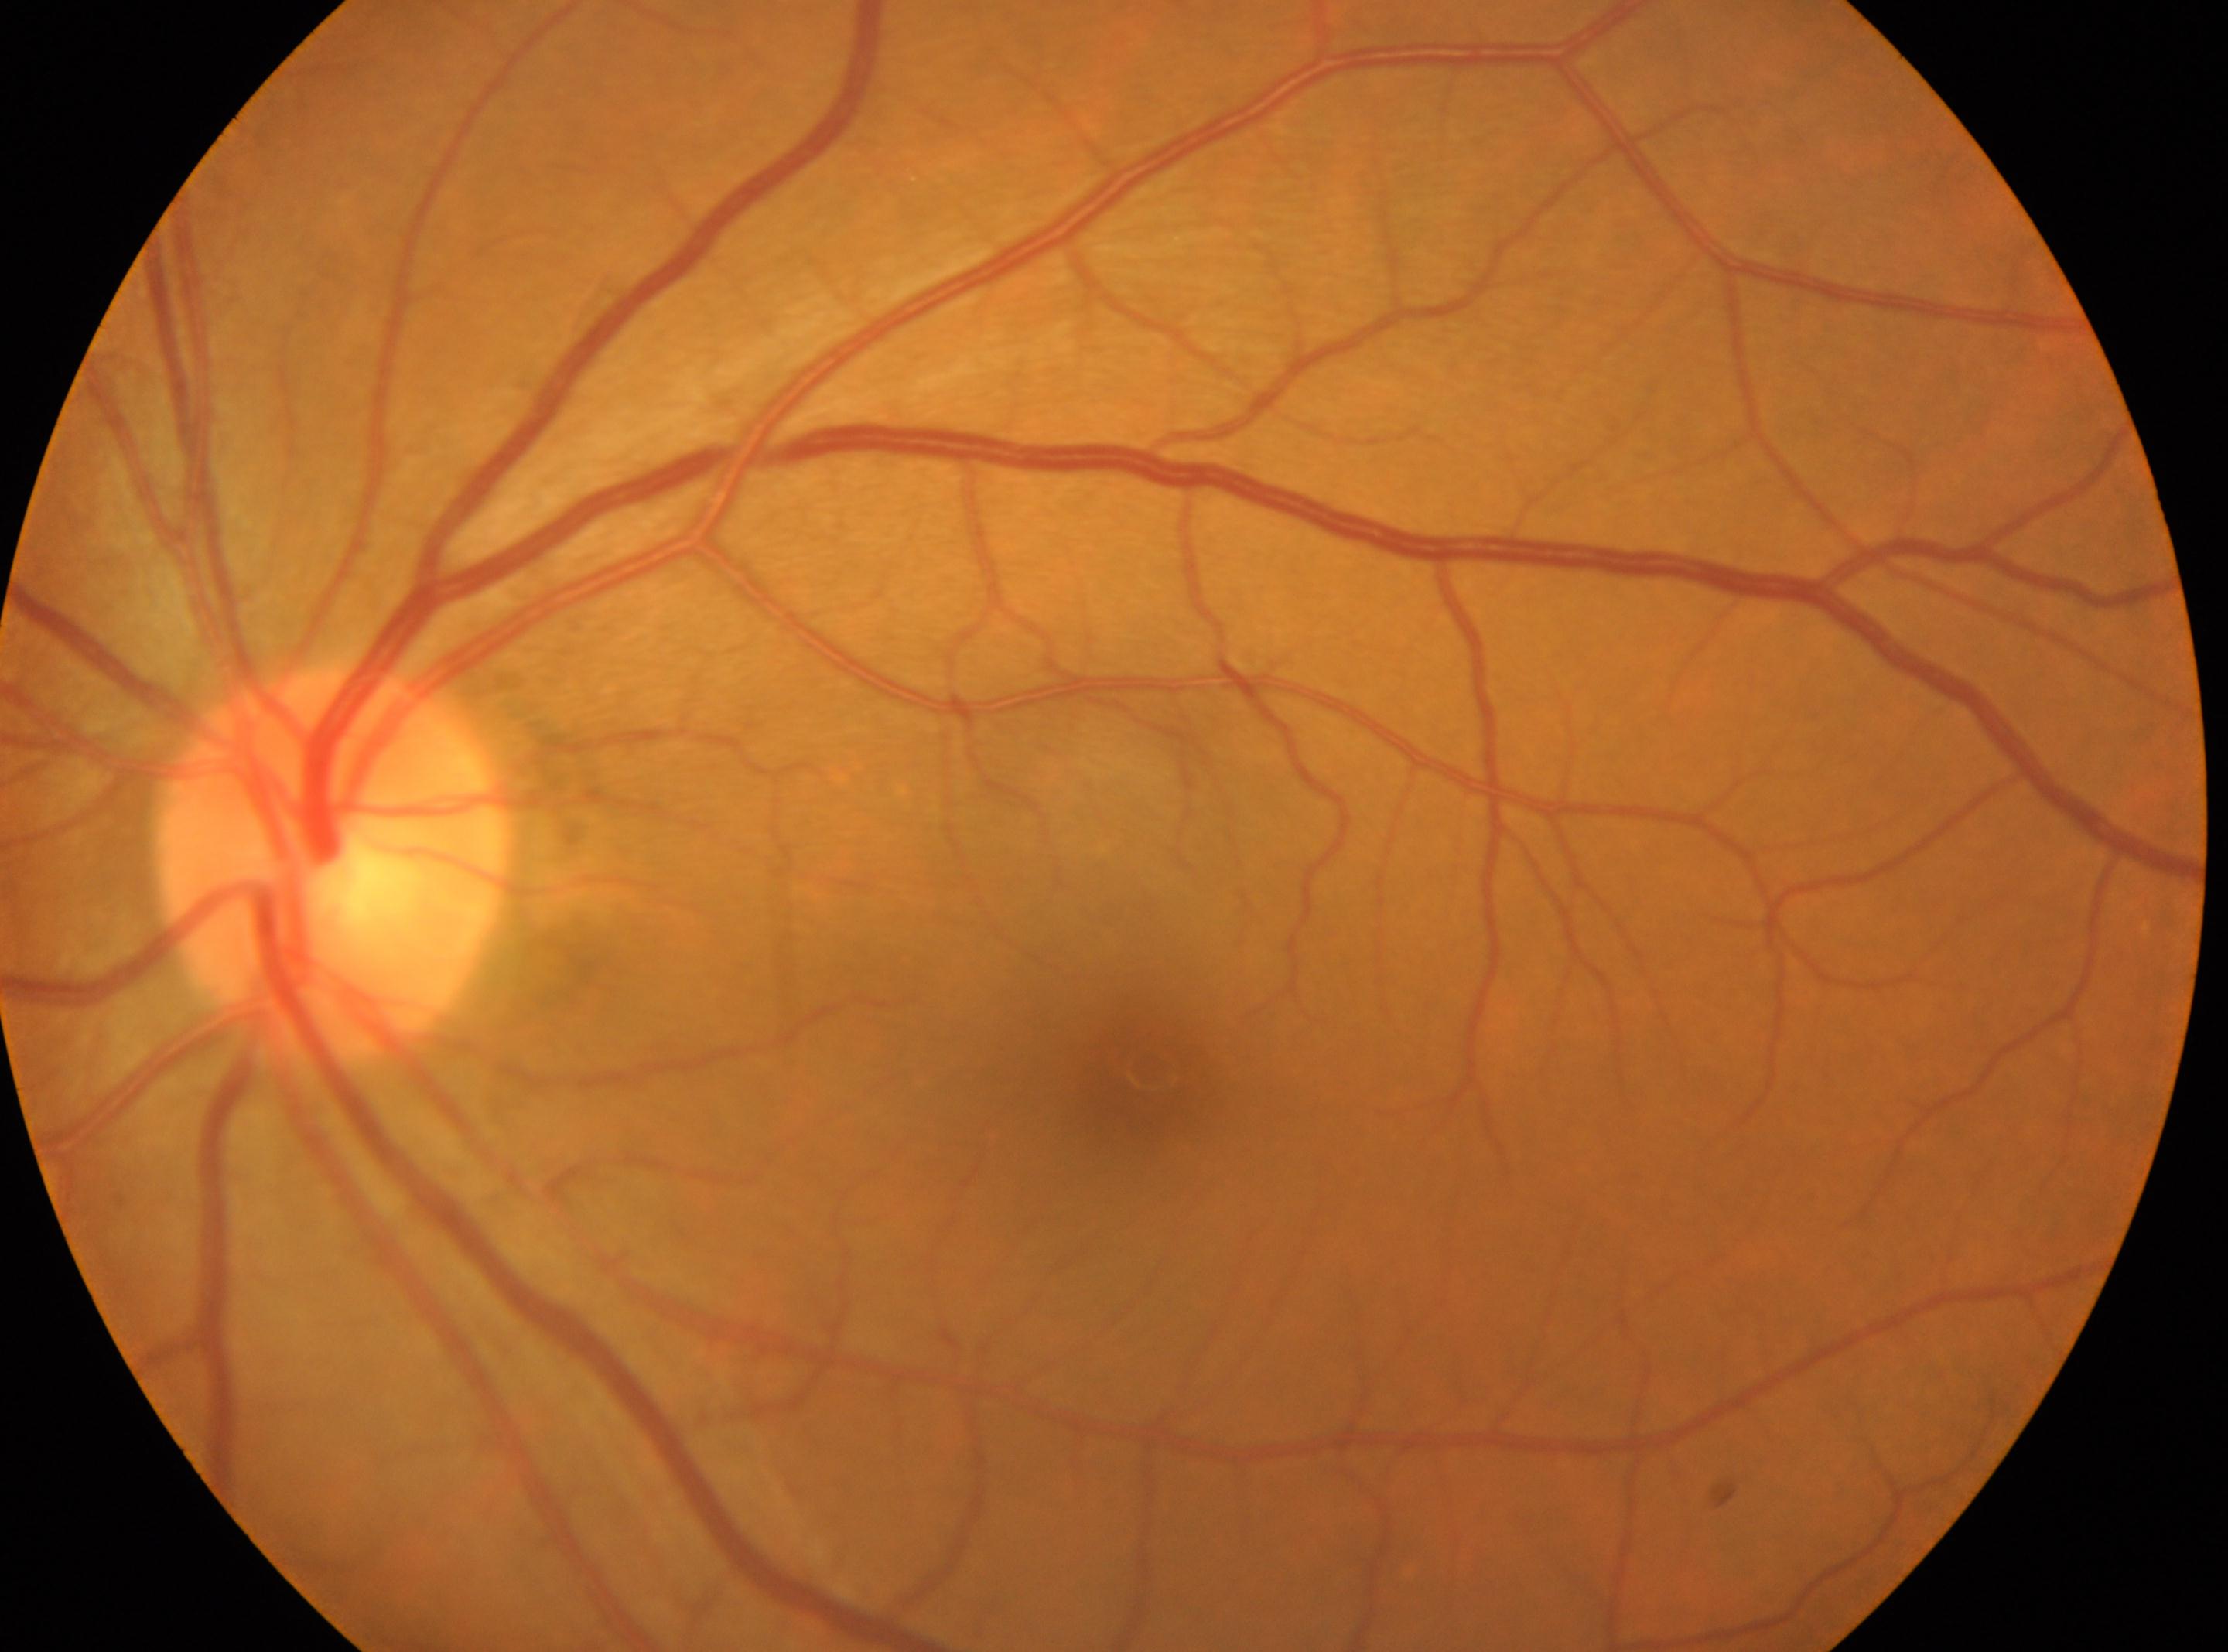 left; fovea center: (1153,1070); optic disc: (333,864); DR: no apparent retinopathy (grade 0).